Color fundus image, 2212 by 1659 pixels, 45-degree field of view — 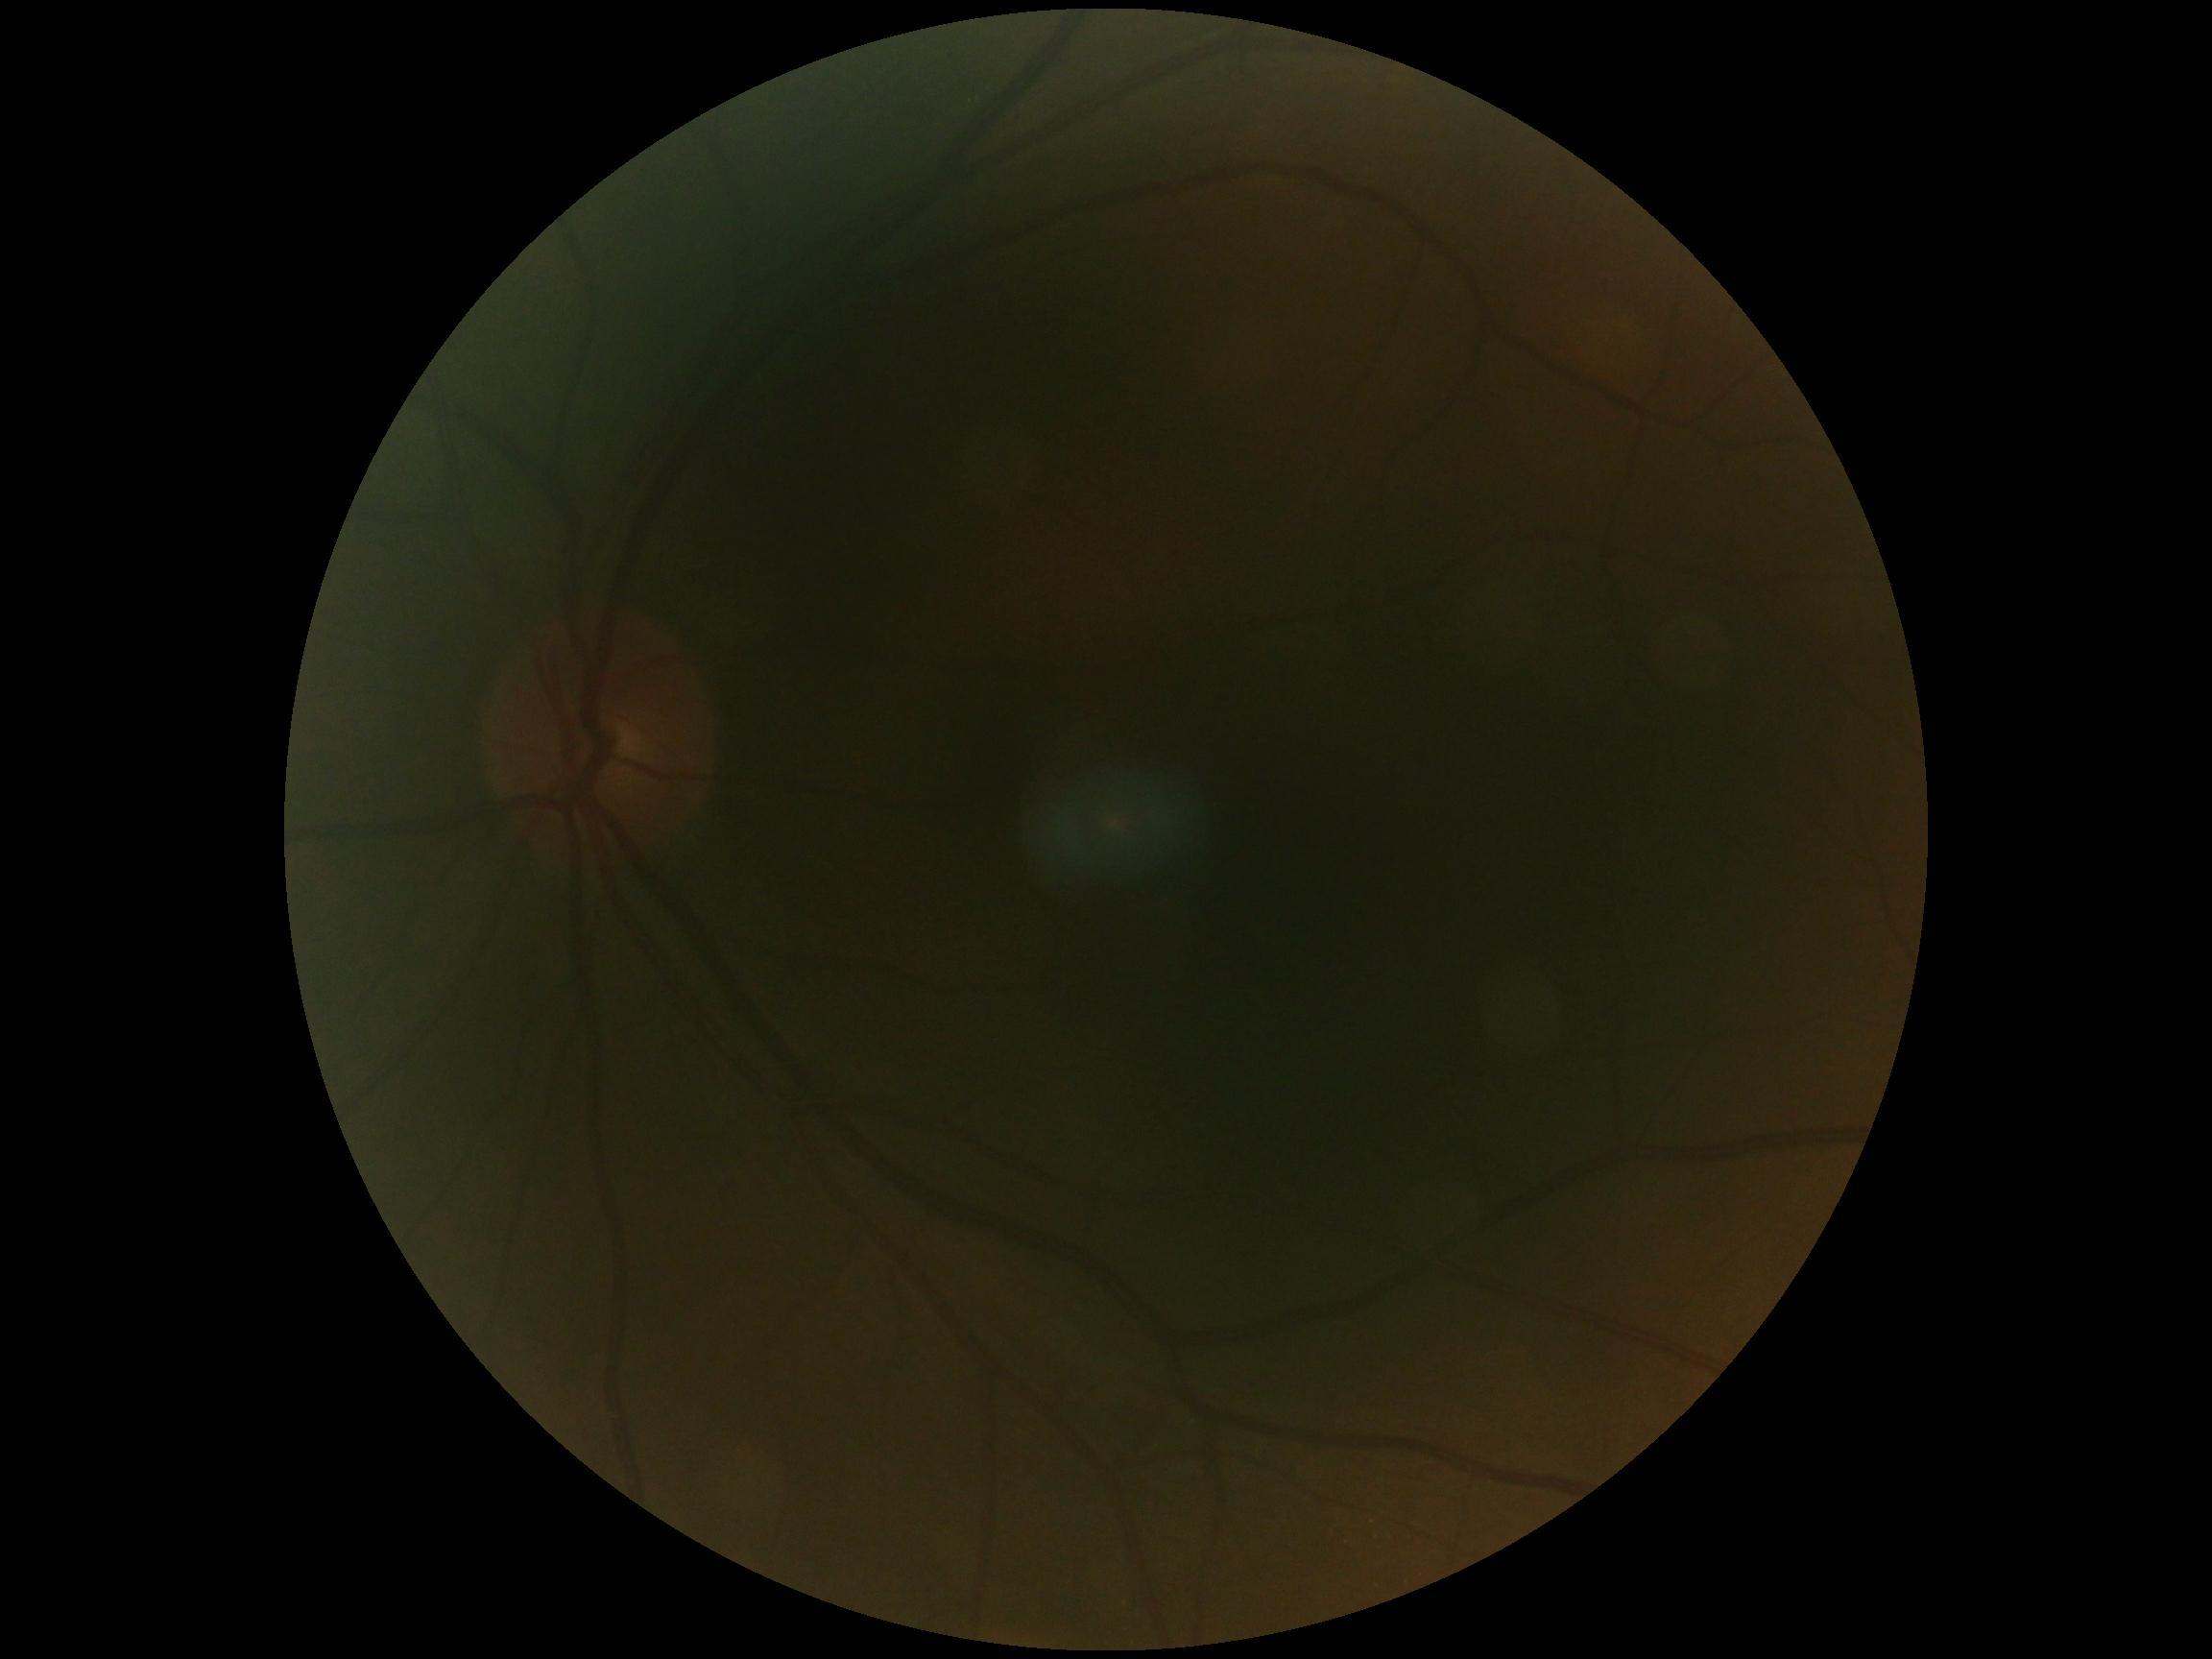
Diabetic retinopathy (DR) is grade 0.